640 x 480 pixels; wide-field fundus photograph of an infant; 130° field of view (Clarity RetCam 3).
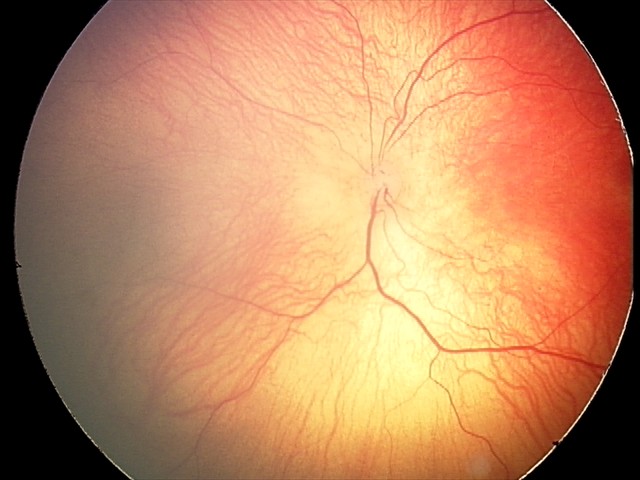

Q: Plus disease status?
A: no plus disease
Q: What was the screening finding?
A: ROP stage 1